130° field of view (Clarity RetCam 3); wide-field fundus photograph of an infant; 640x480
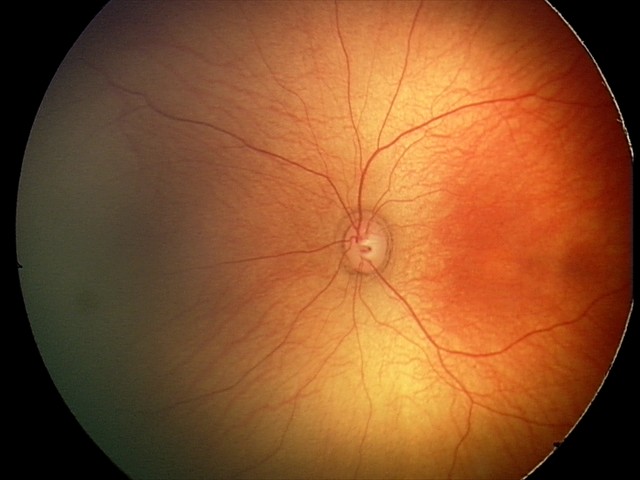
Q: What was the screening finding?
A: normal retinal appearance